Macula-centered. 50° field of view.
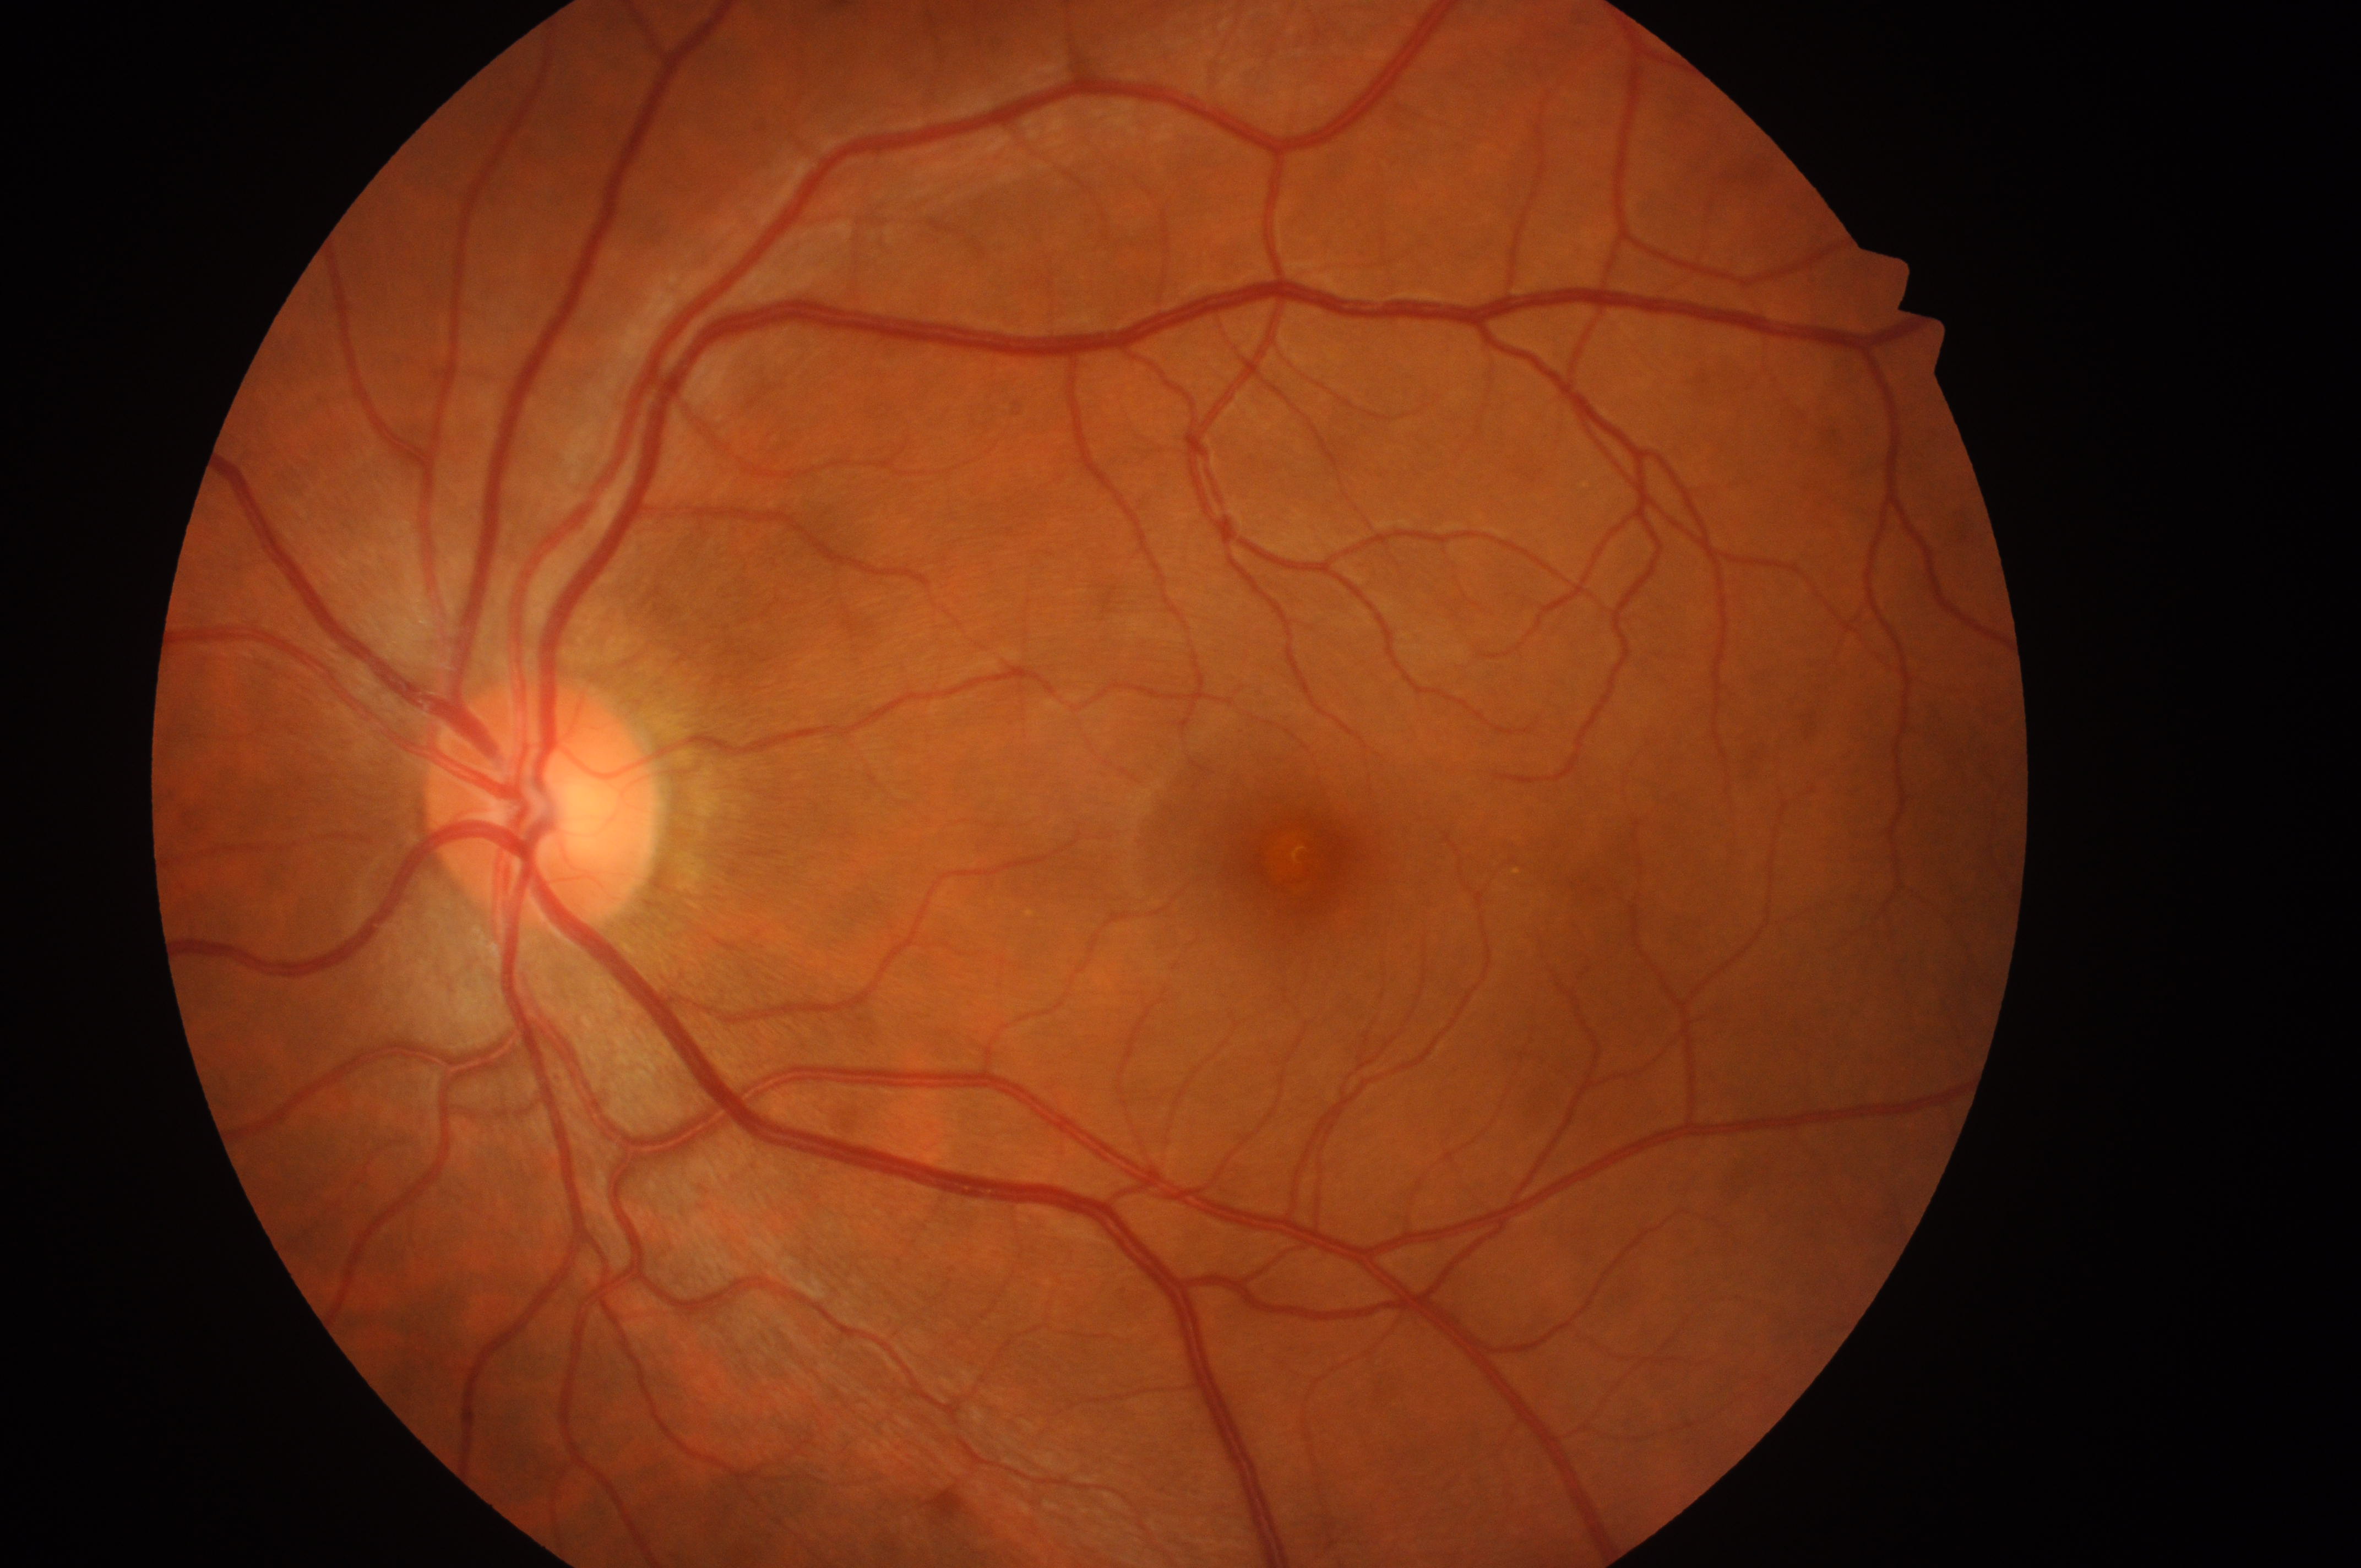 diabetic macular edema = no risk (grade 0) | the fovea = x=1299, y=859 | retinopathy = grade 0 (no apparent retinopathy) | disc center = x=540, y=812 | laterality = left eye.